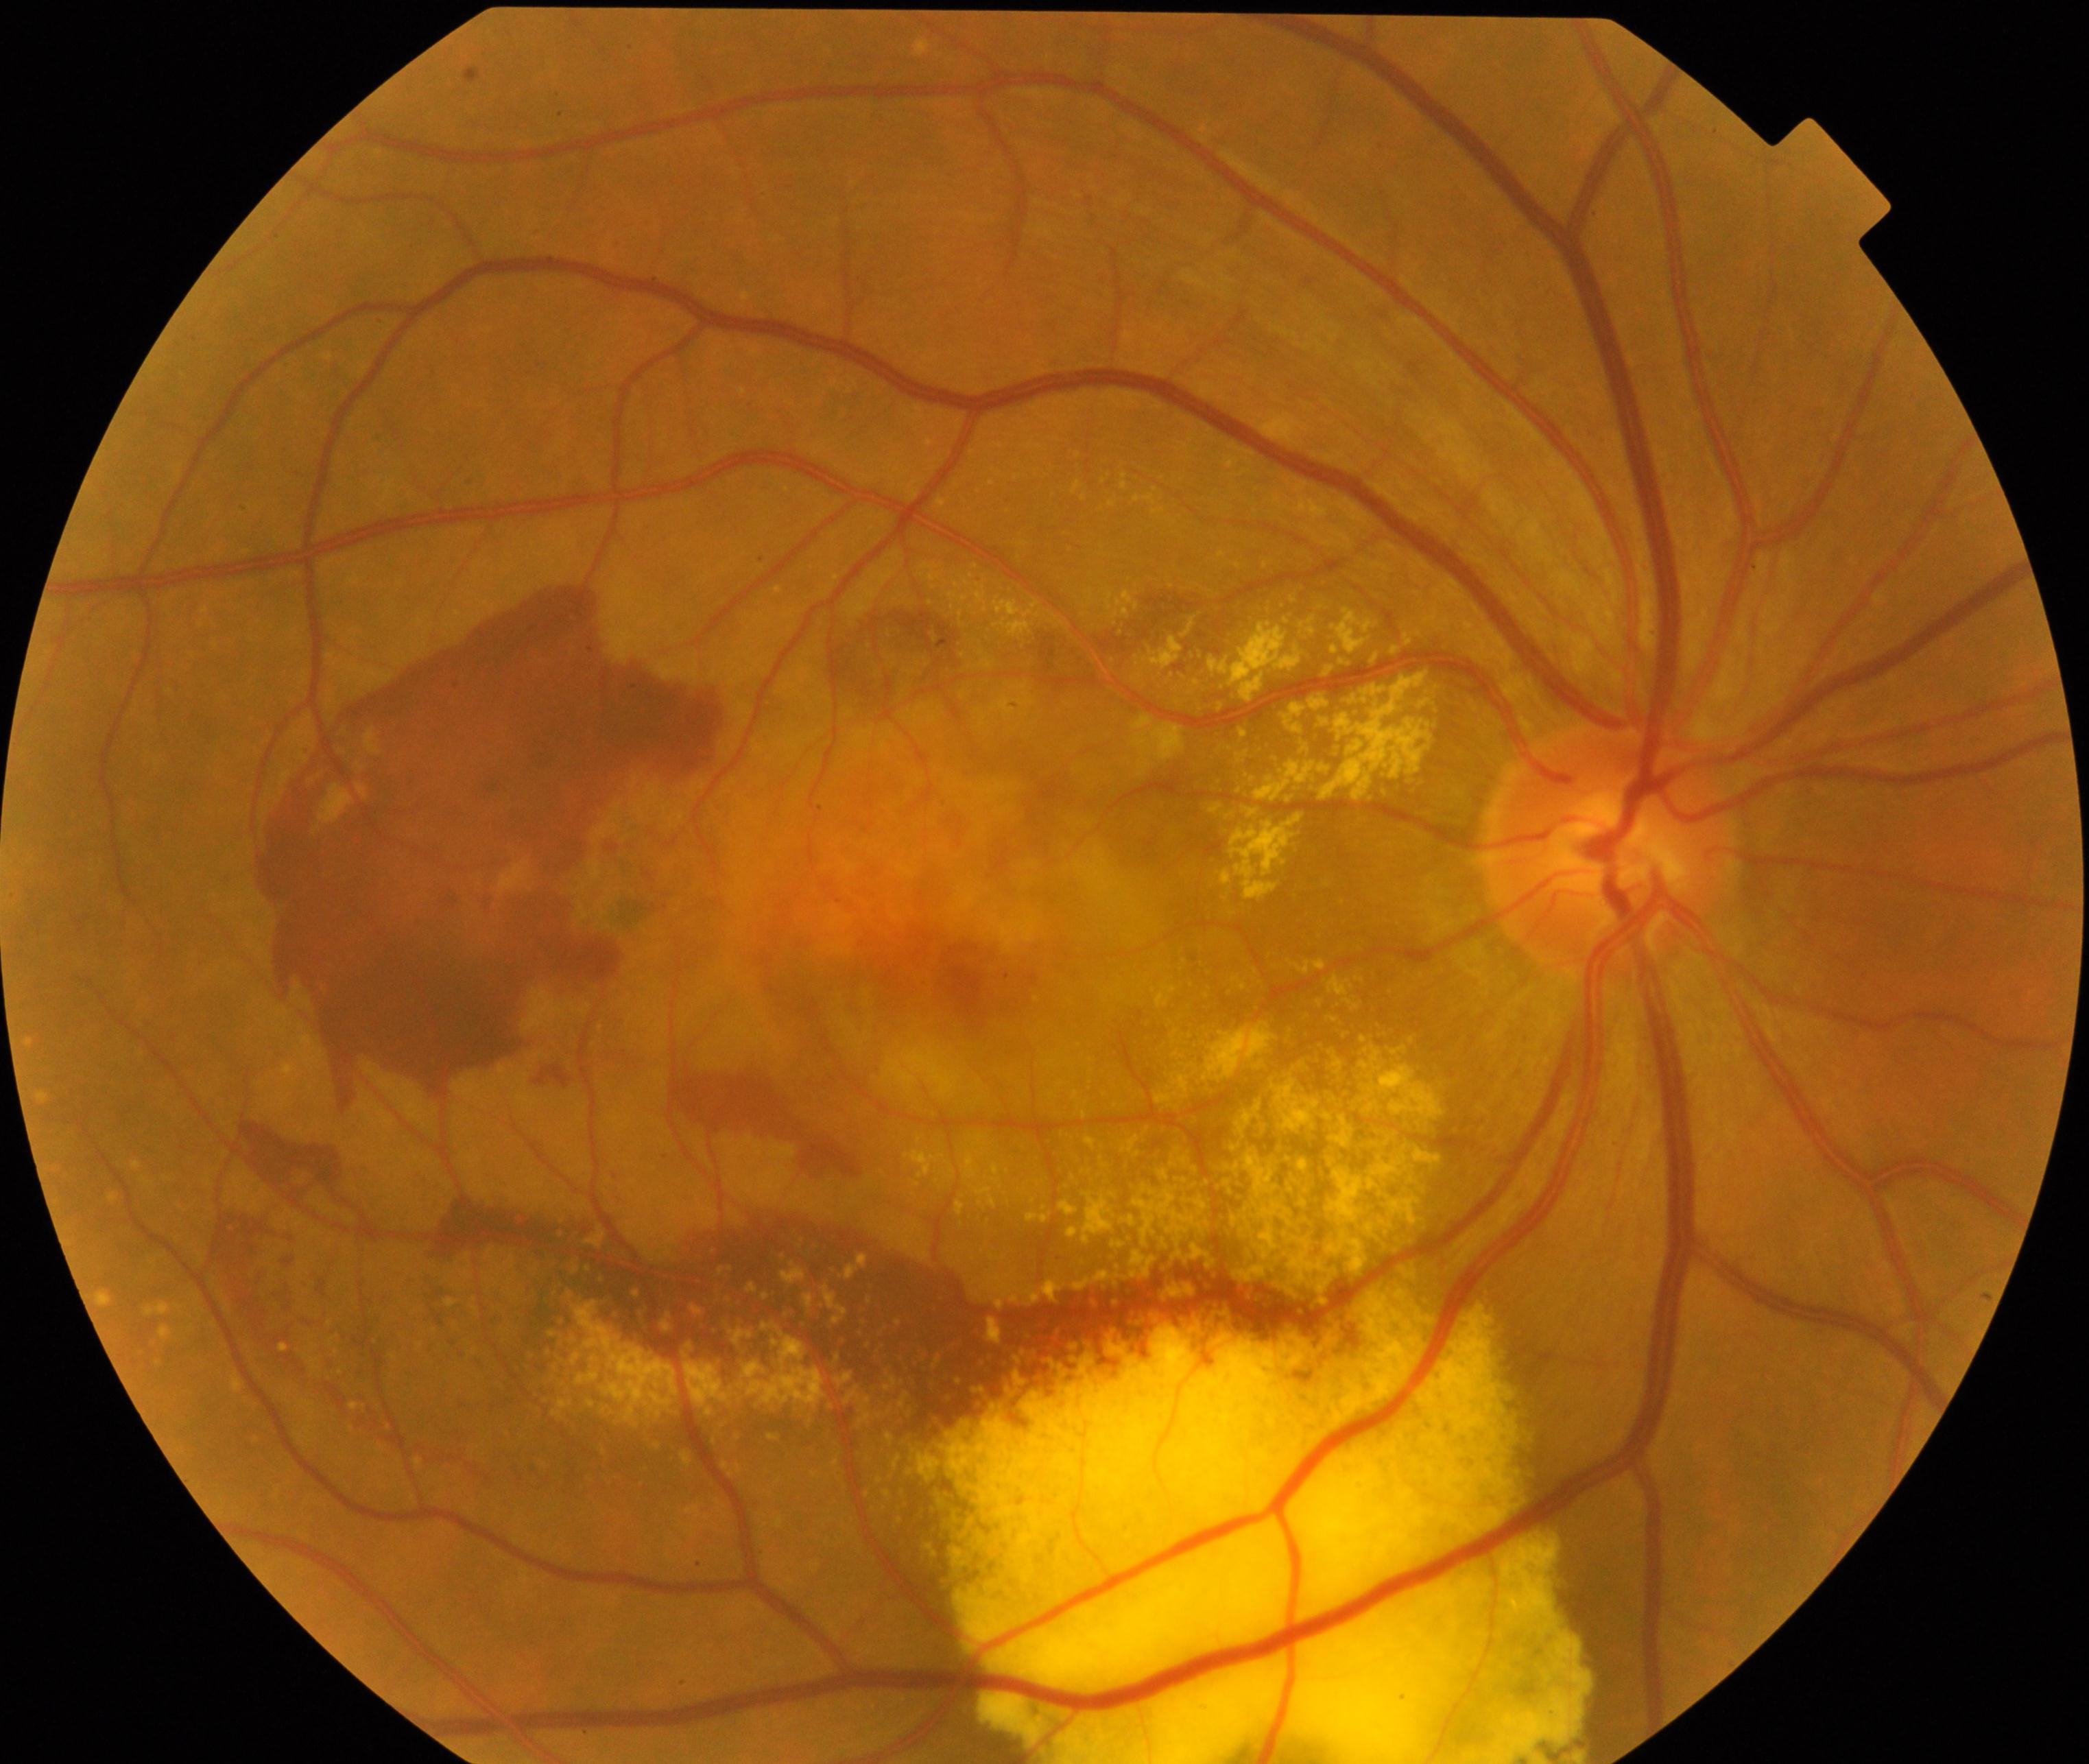 Diagnosis: maculopathy. Defined by lesions within the macular area, such as intermediate or neovascular age-related macular degeneration, retinal angiomatous proliferation, polypoidal choroidal vasculopathy, choroidal neovascularization, idiopathic macular telangiectasia, and macular atrophy, not caused by other listed disease categories.